Topcon TRC retinal camera, IMAGEnet capture system; ONH-centered crop from a color fundus image:
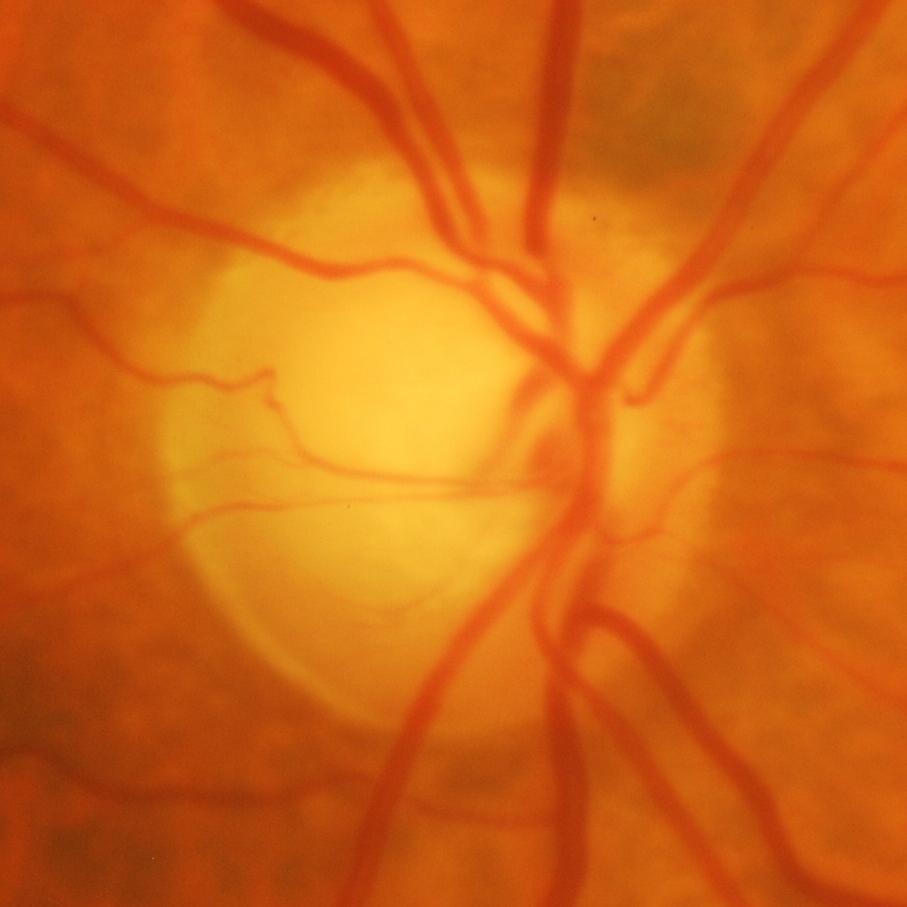
The image shows glaucomatous damage to the optic nerve.